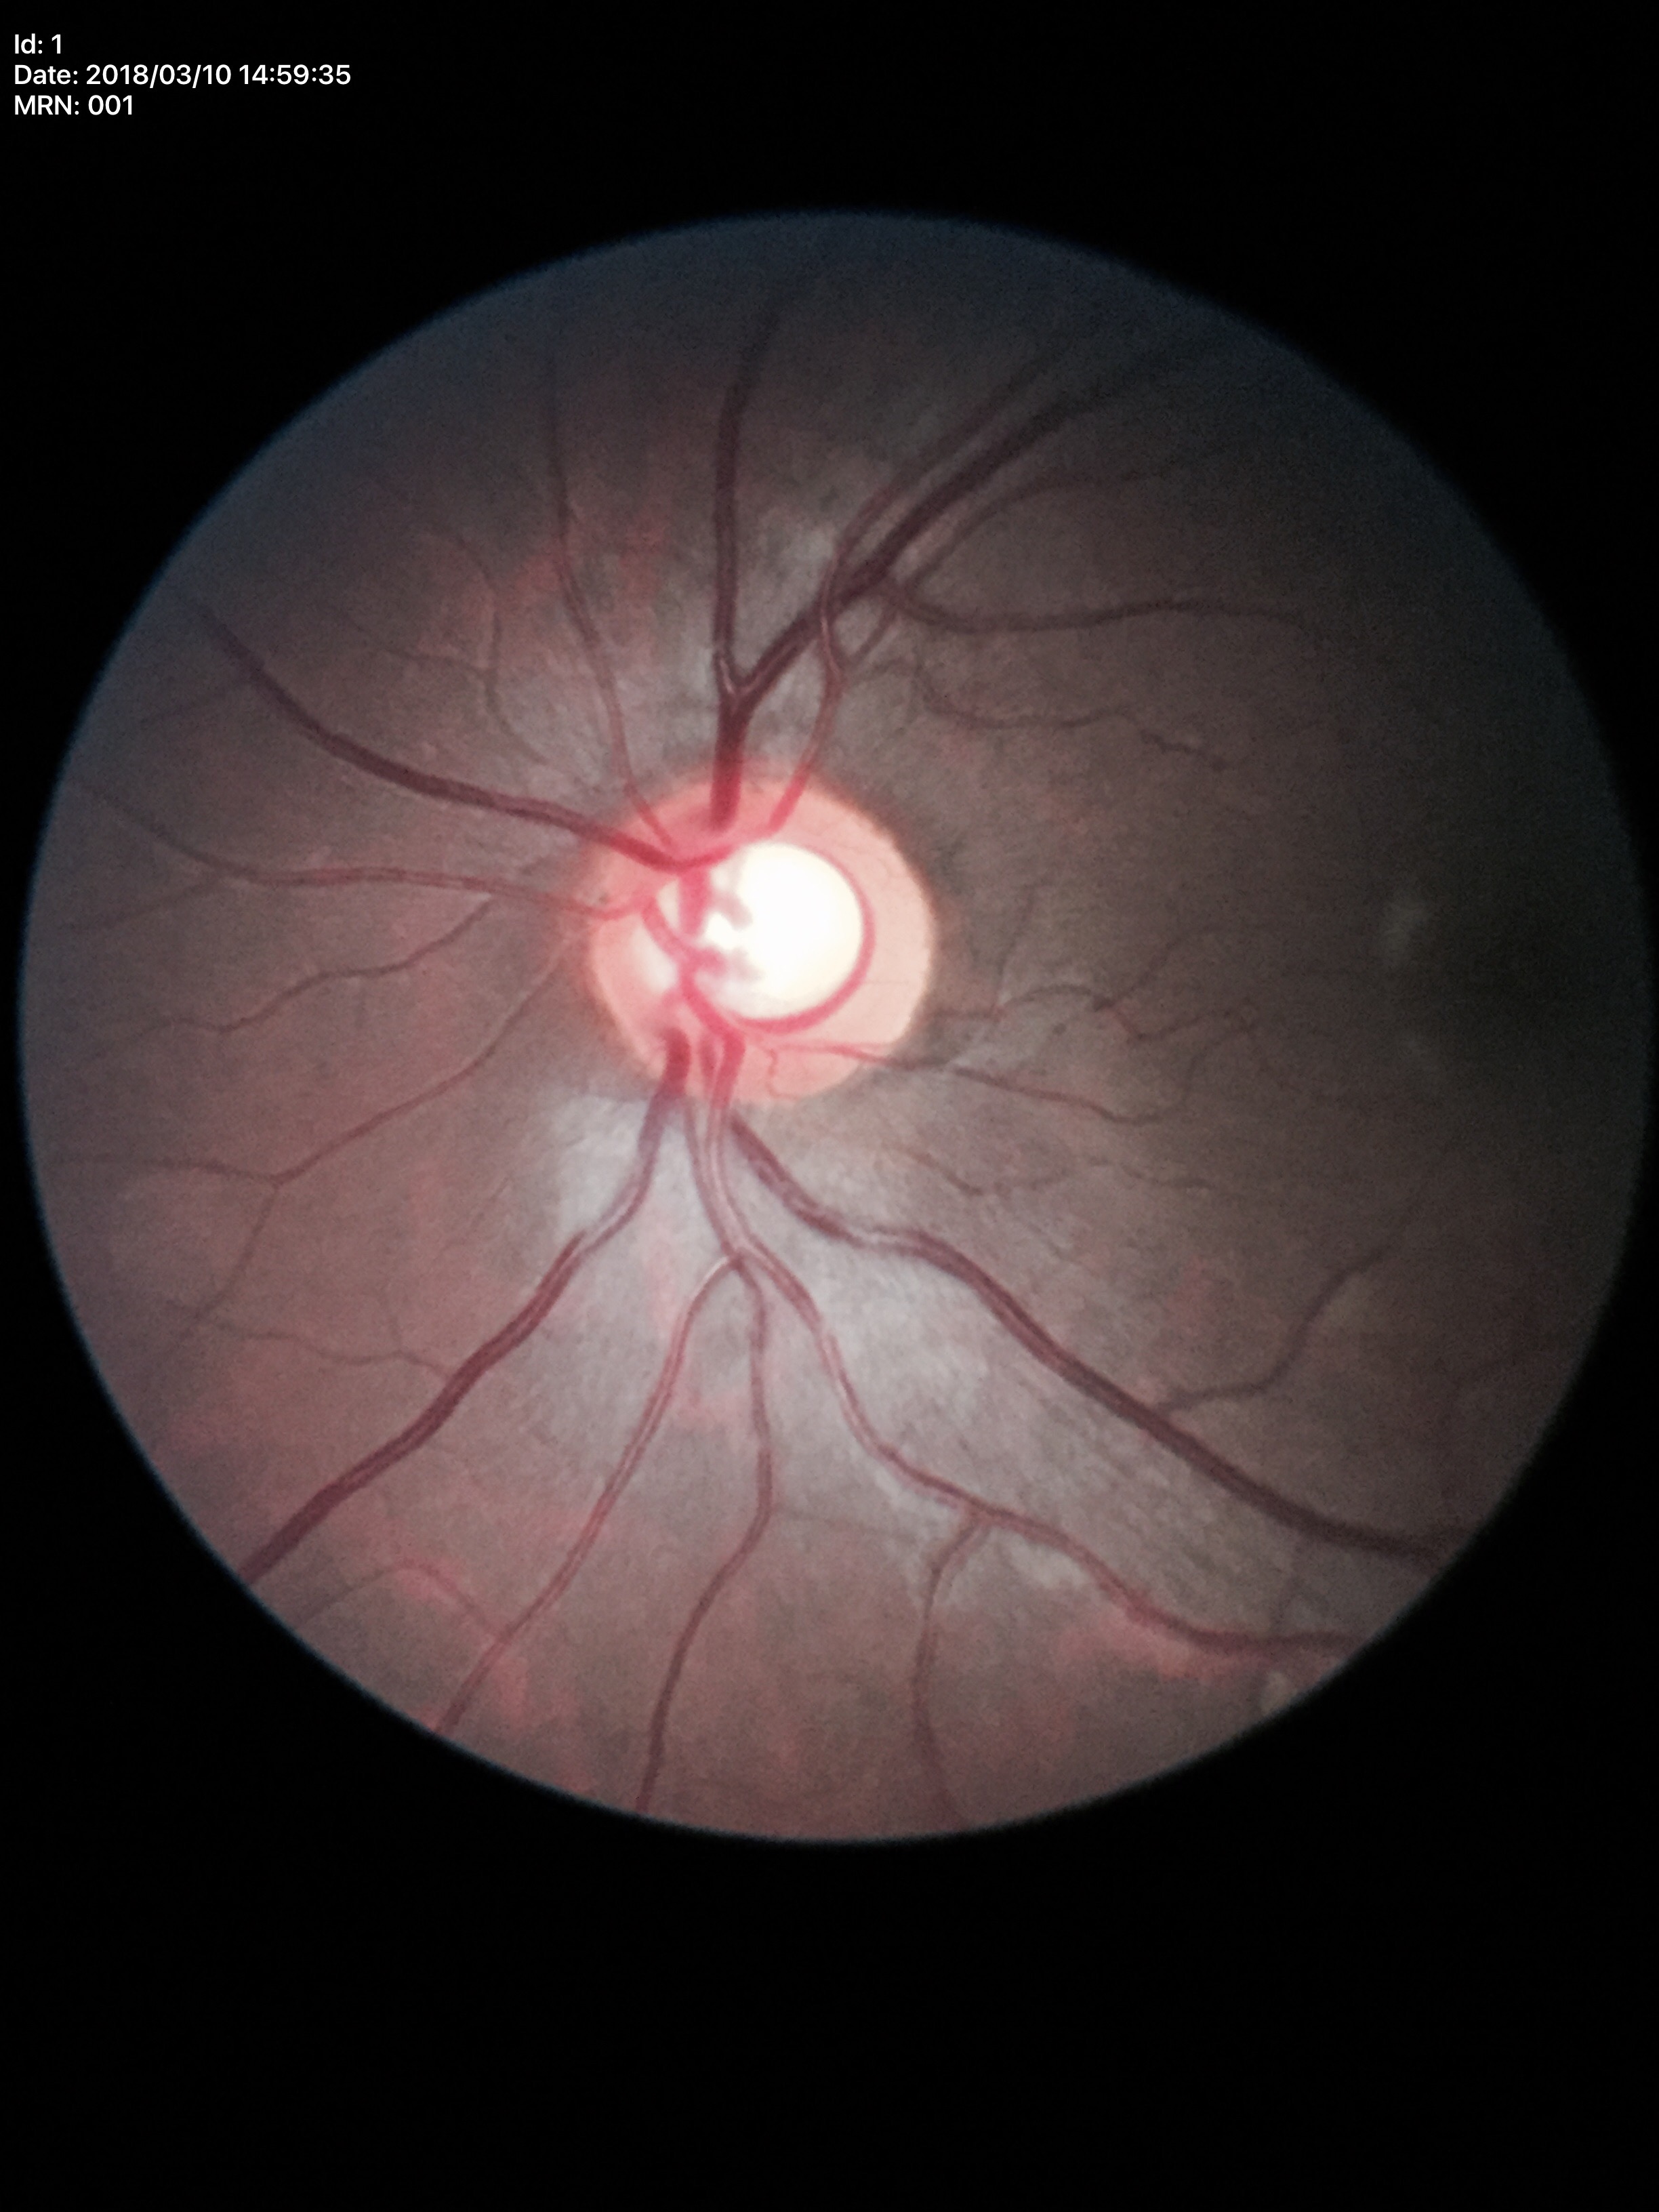 - Glaucoma decision — suspect
- vertical CDR (VCDR) — 0.63